Diabetic retinopathy graded by the modified Davis classification: 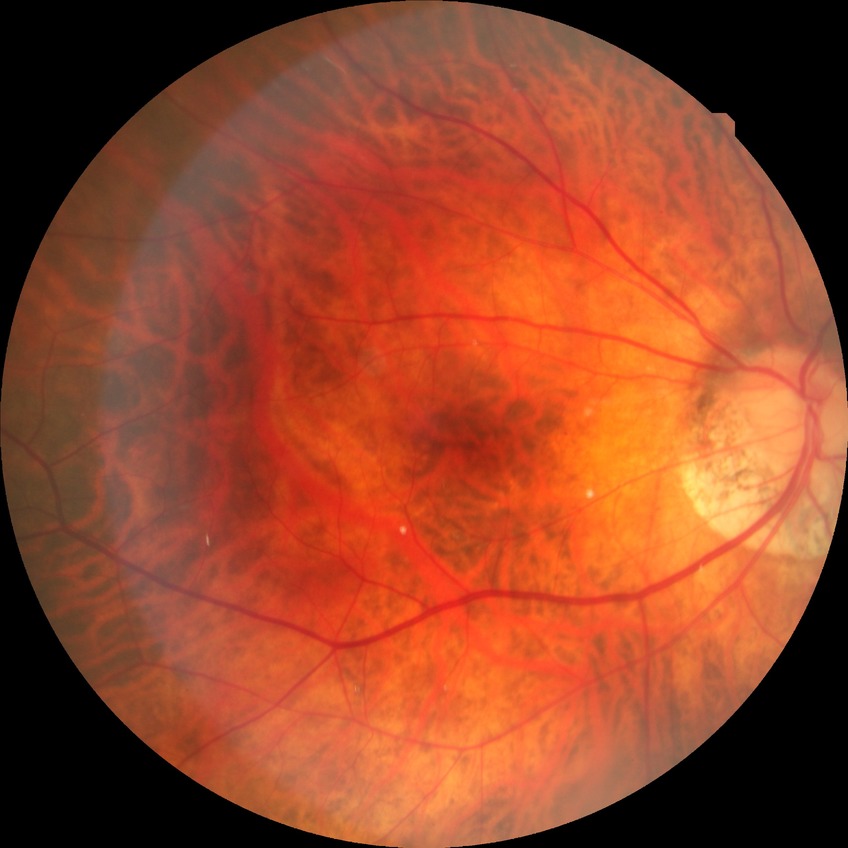 diabetic retinopathy (DR): NDR (no diabetic retinopathy).